NIDEK AFC-230 fundus camera, Davis DR grading
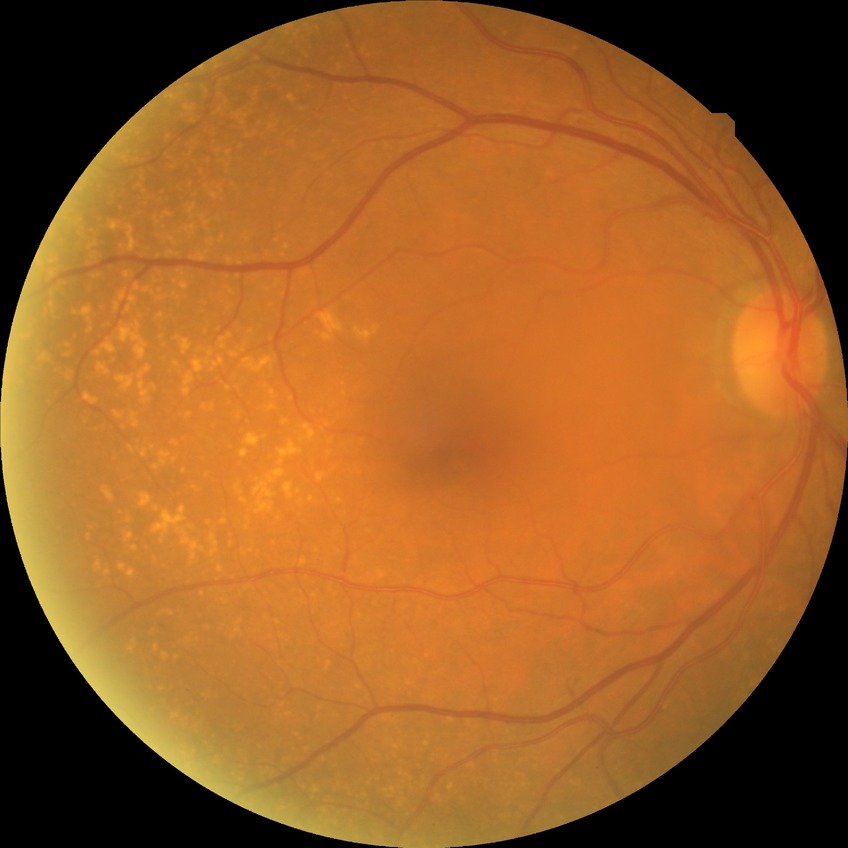 Annotations:
- diabetic retinopathy (DR) — NDR (no diabetic retinopathy)